Wide-field fundus photograph from neonatal ROP screening — 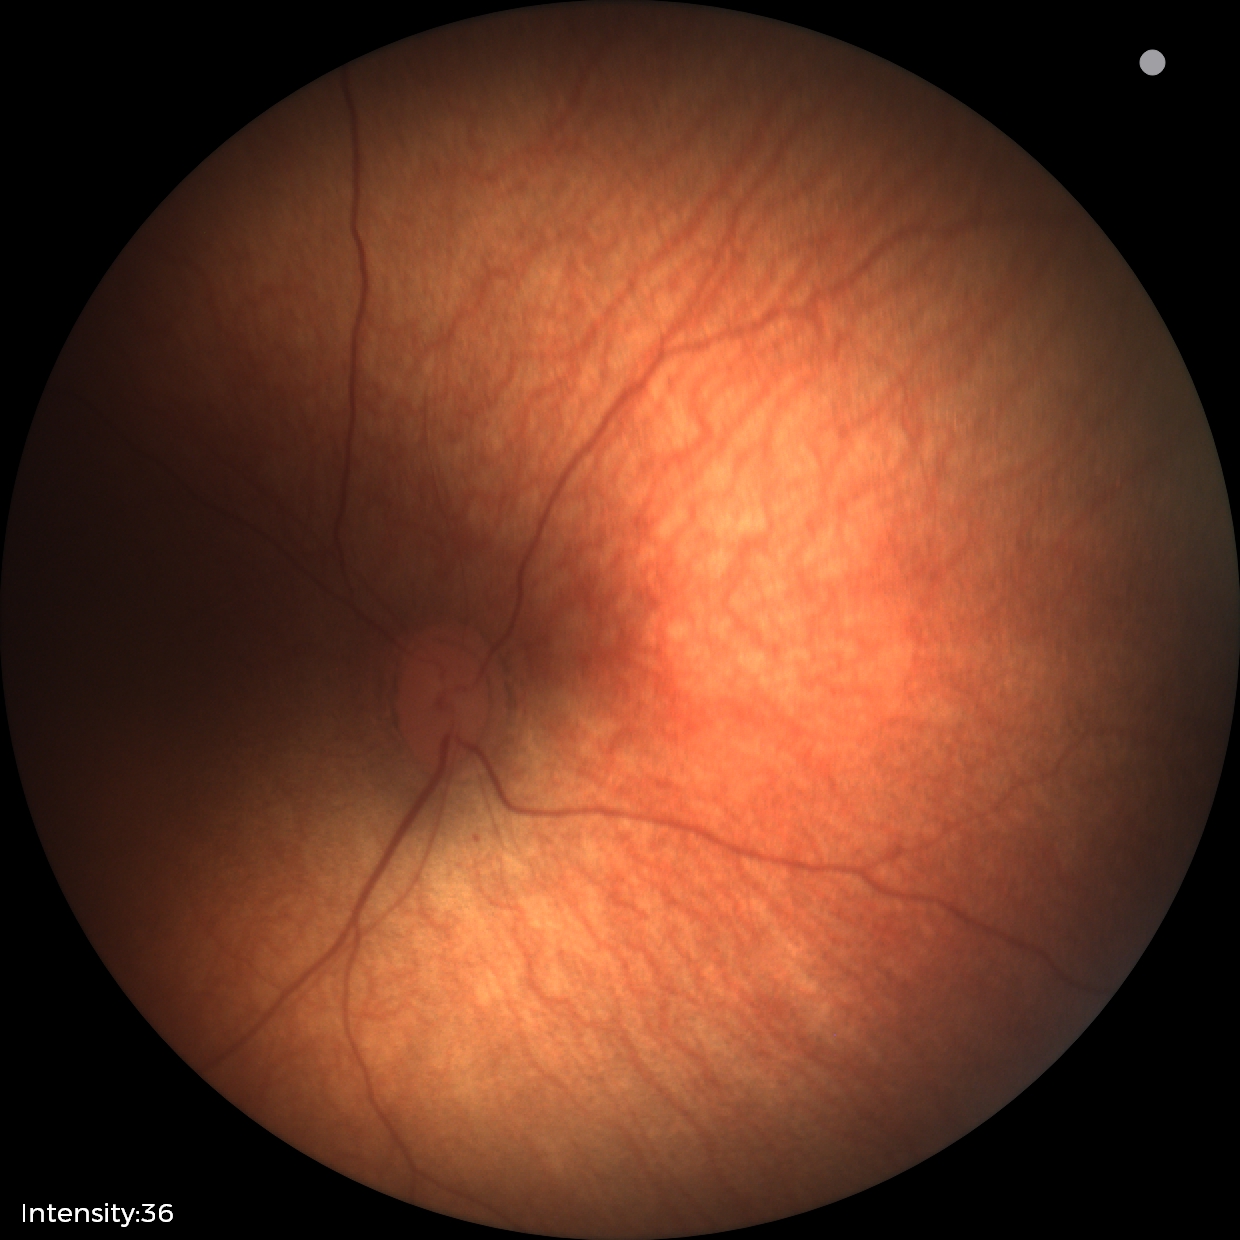

Screening examination diagnosed as physiological.